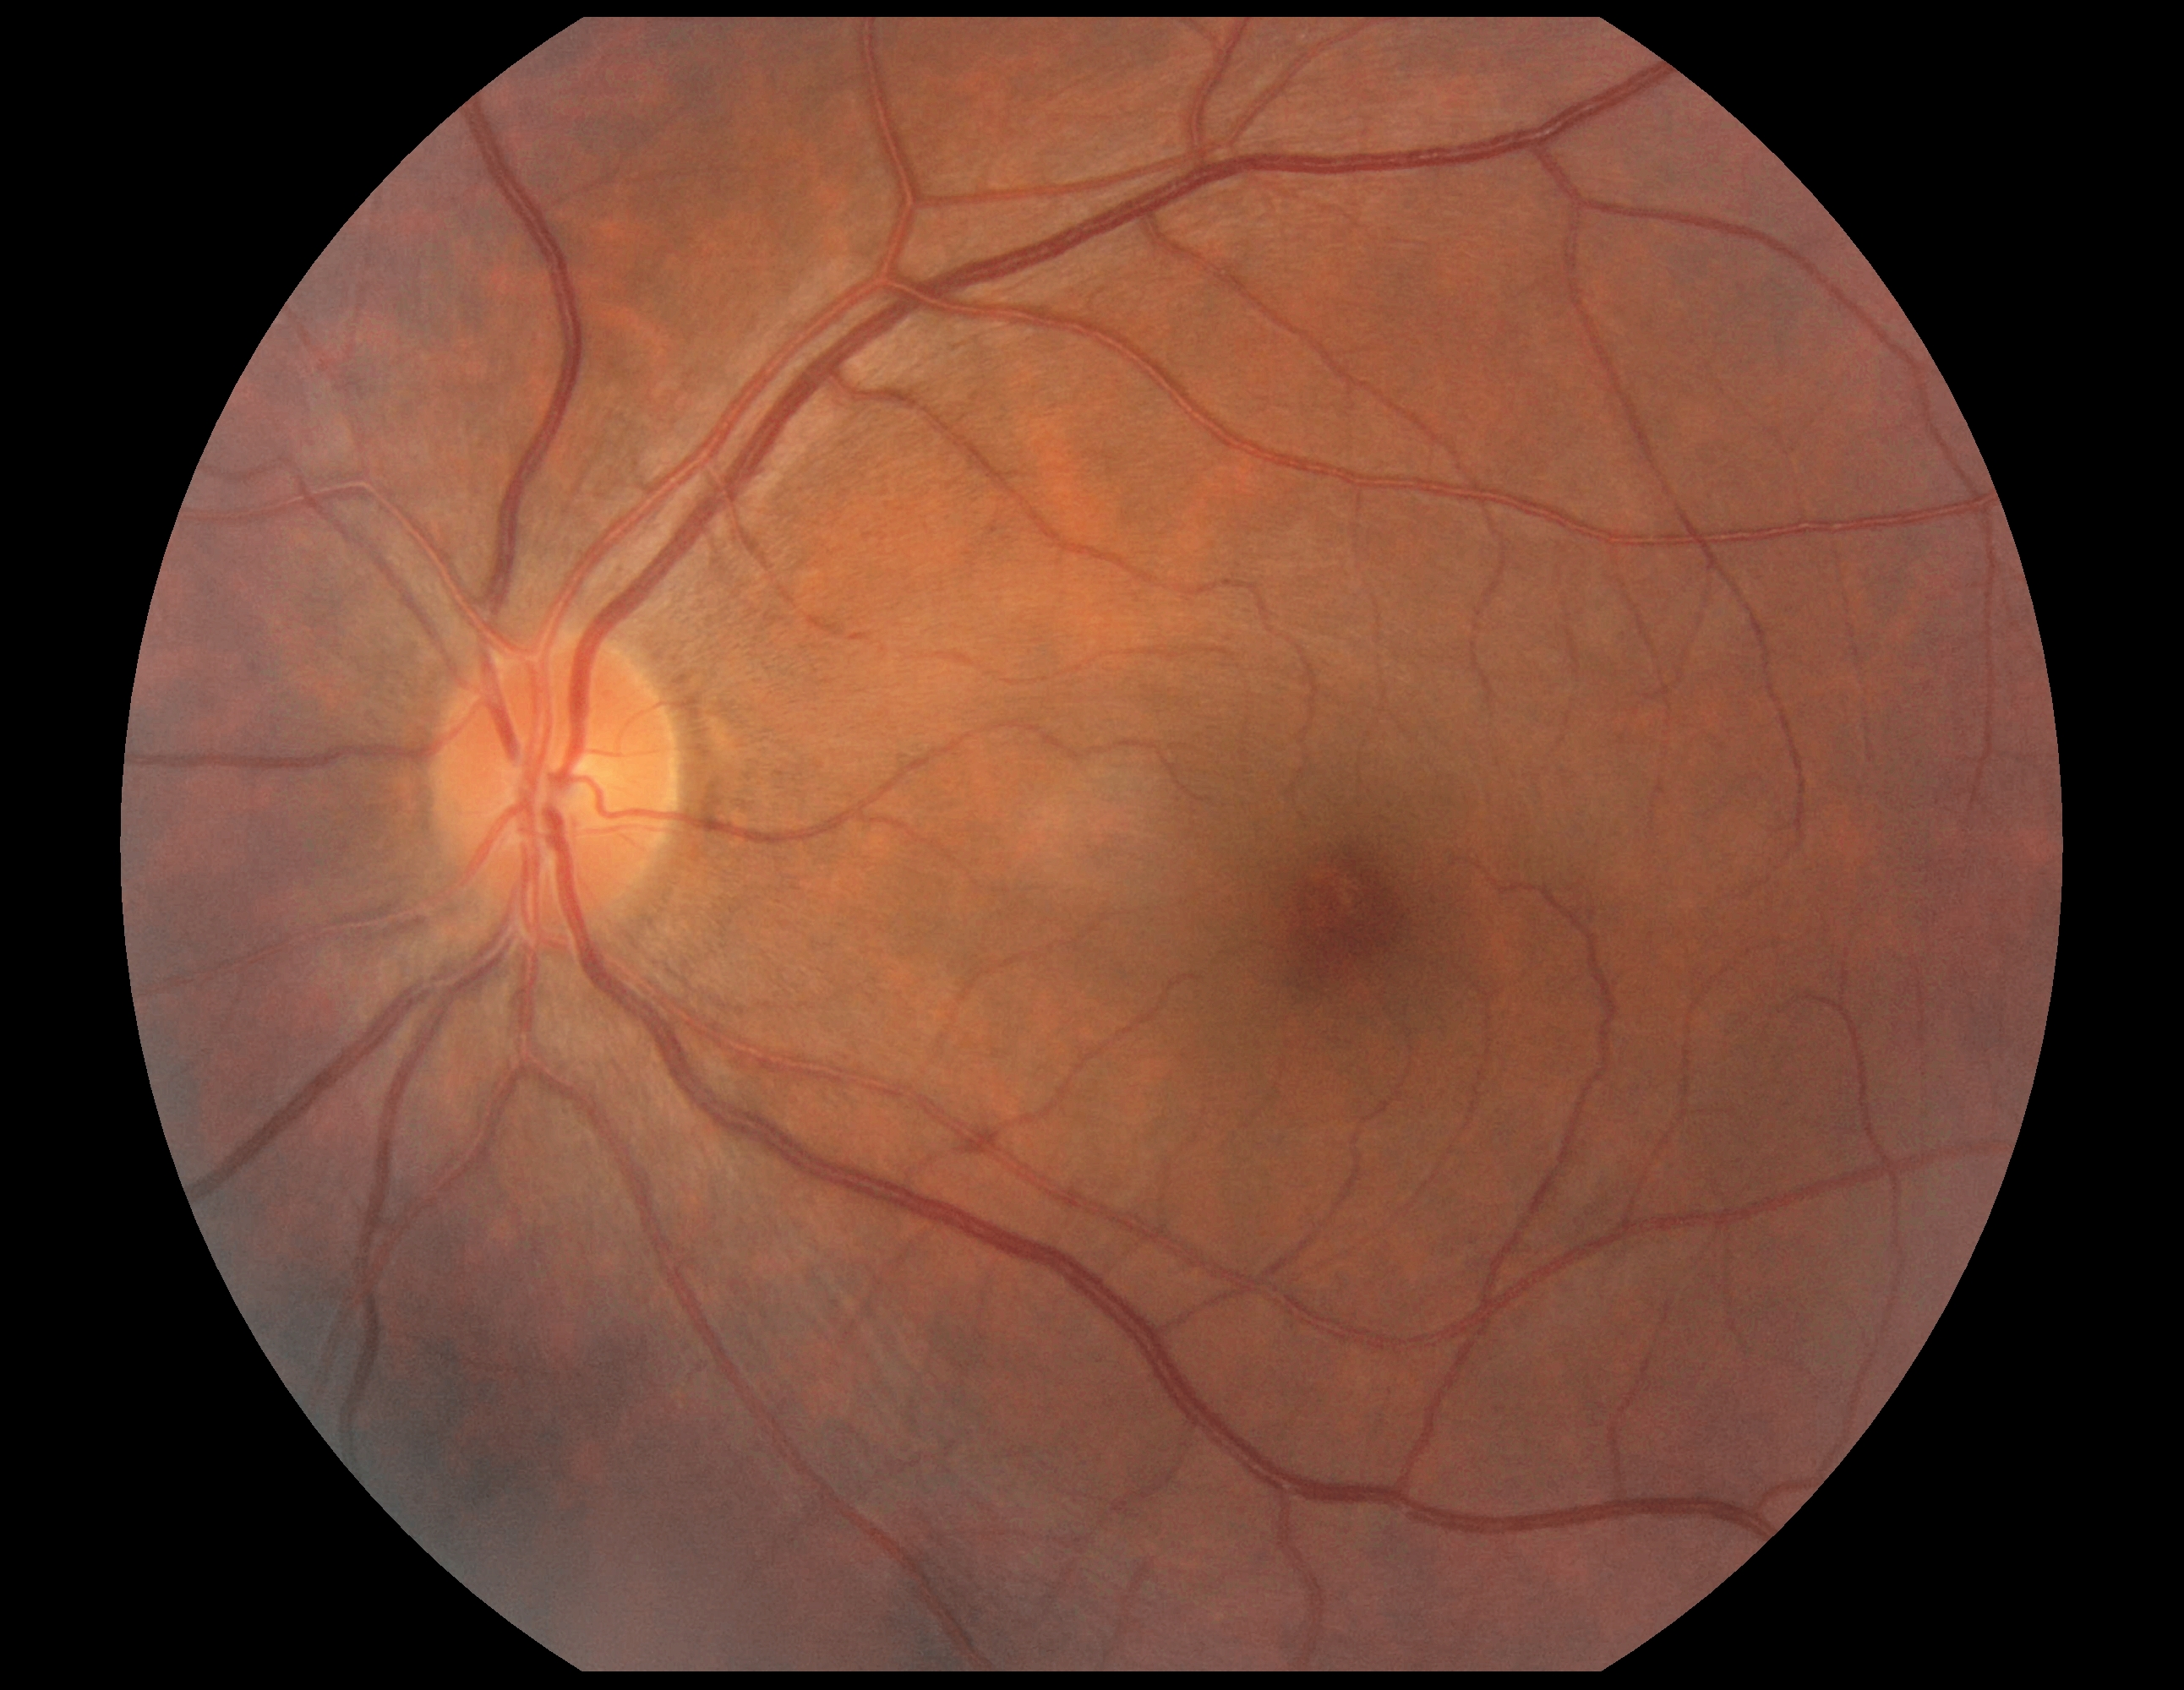

No signs of diabetic retinopathy. Retinopathy is grade 0 (no apparent retinopathy).